Wide-field fundus photograph of an infant — 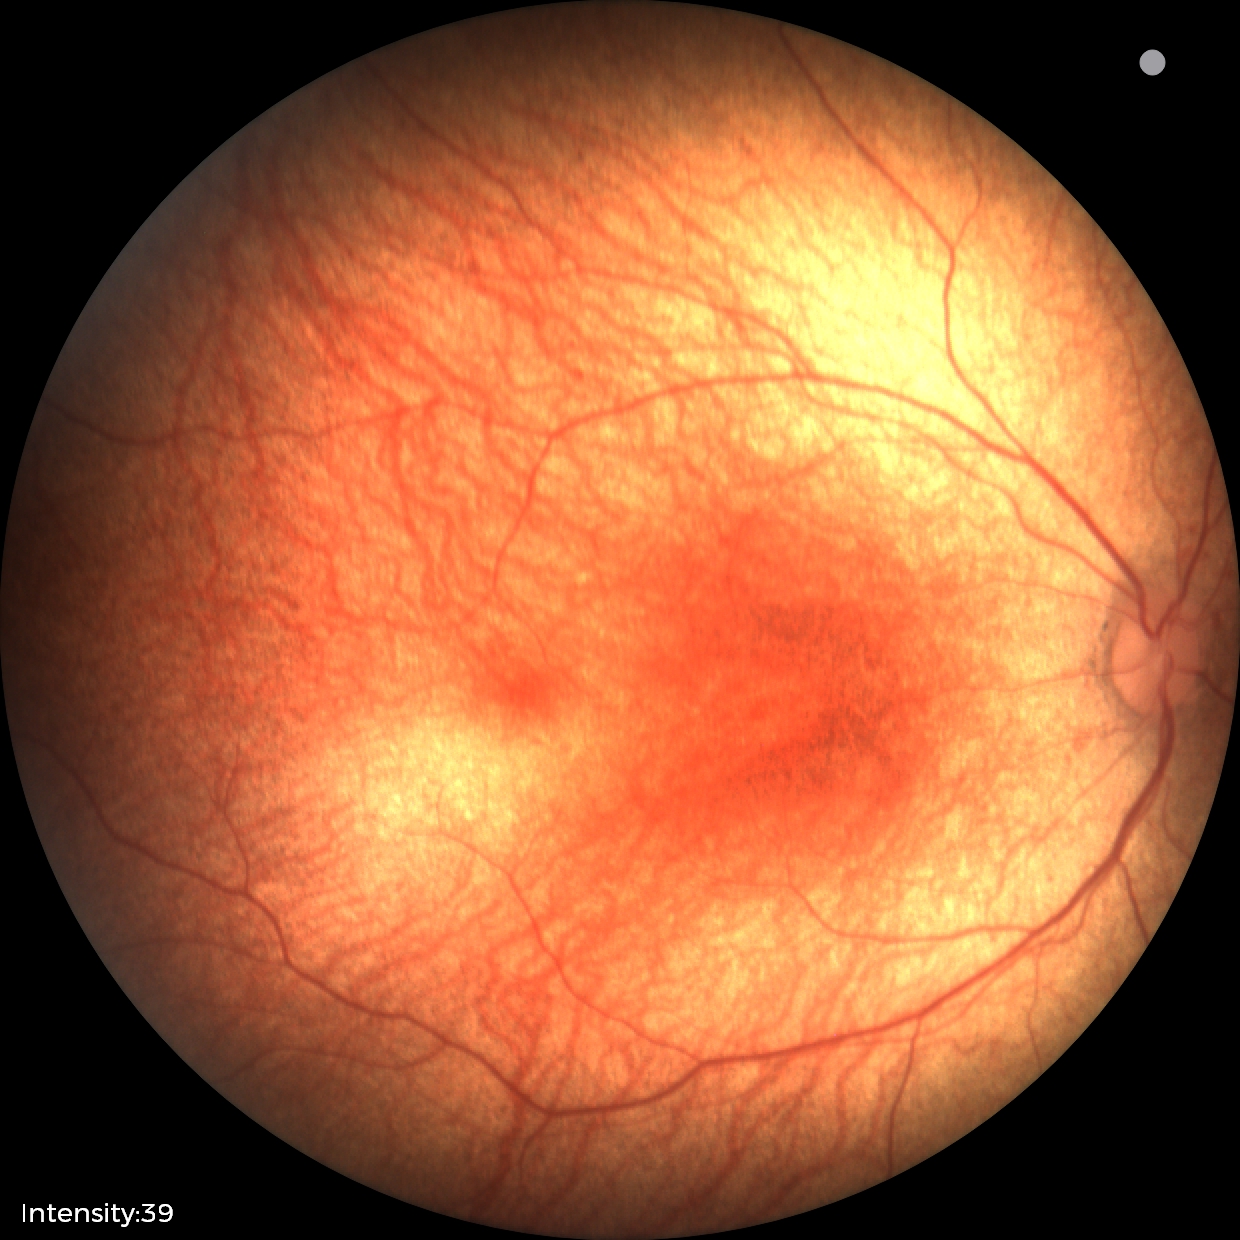
Examination with physiological retinal findings.